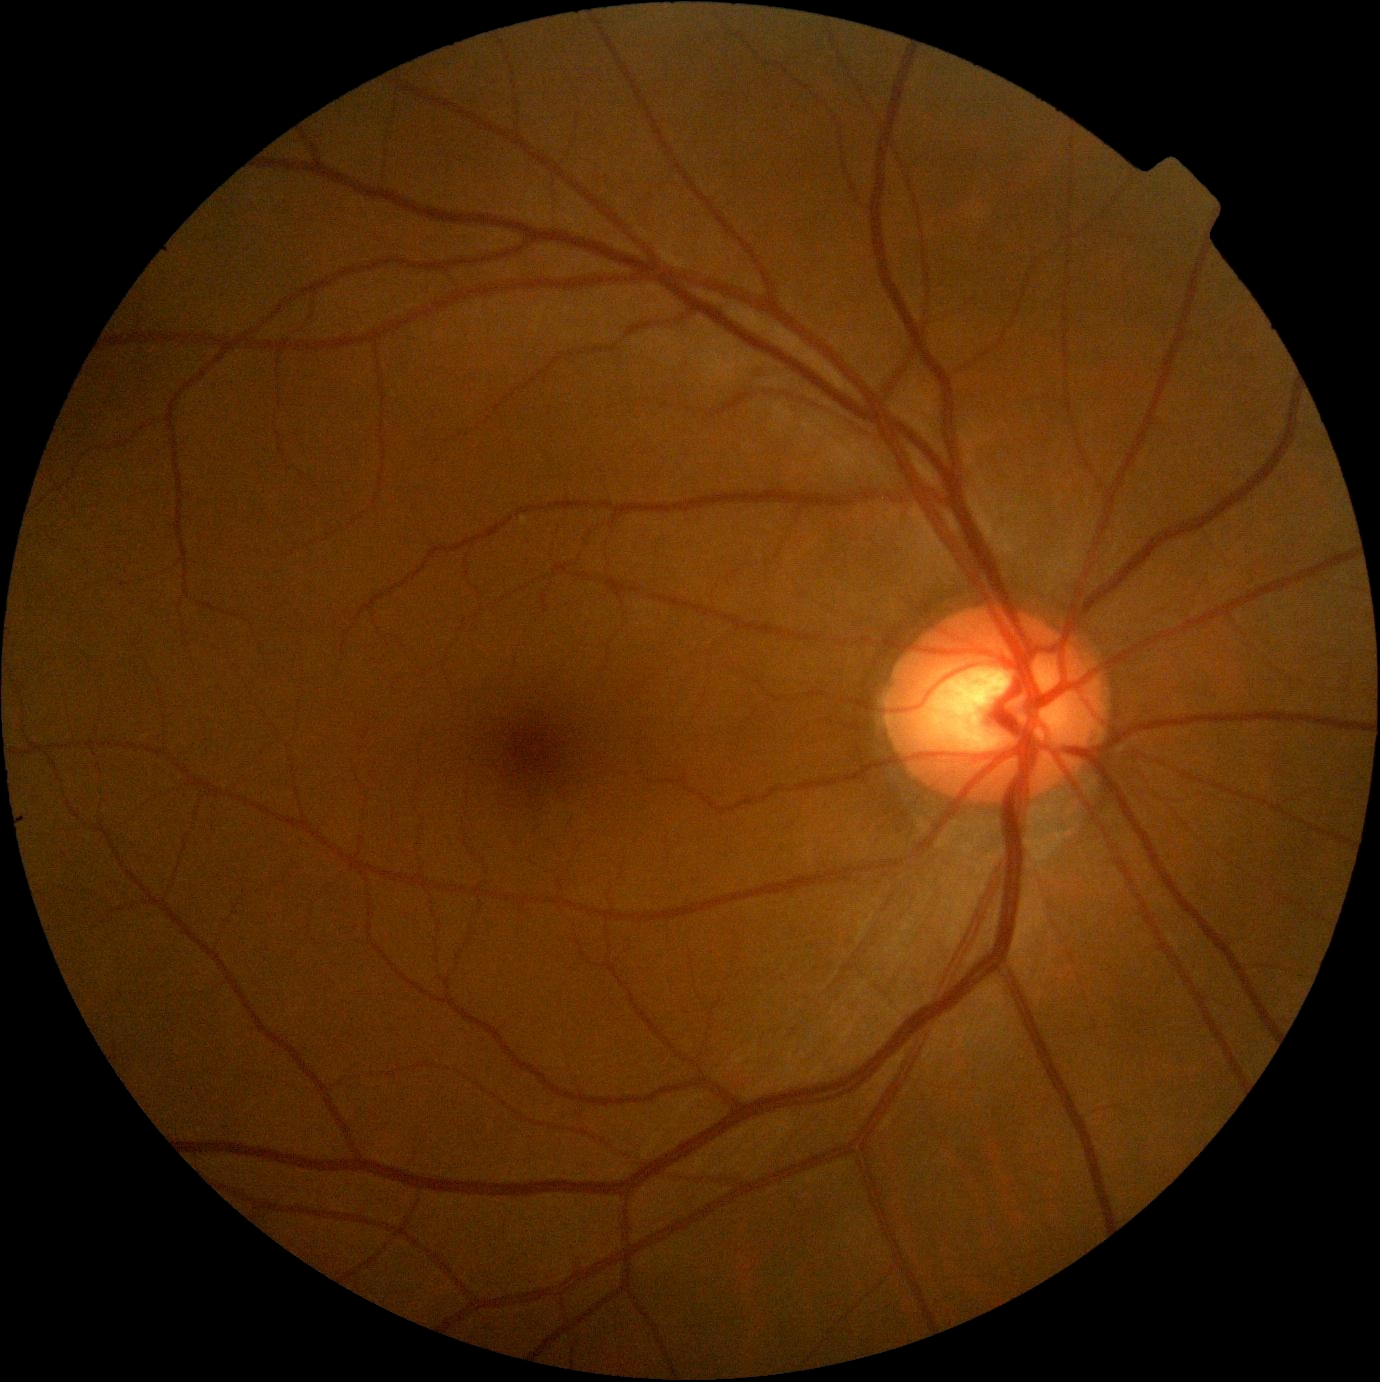
No signs of diabetic retinopathy.
Diabetic retinopathy: 0.